FOV: 45 degrees.
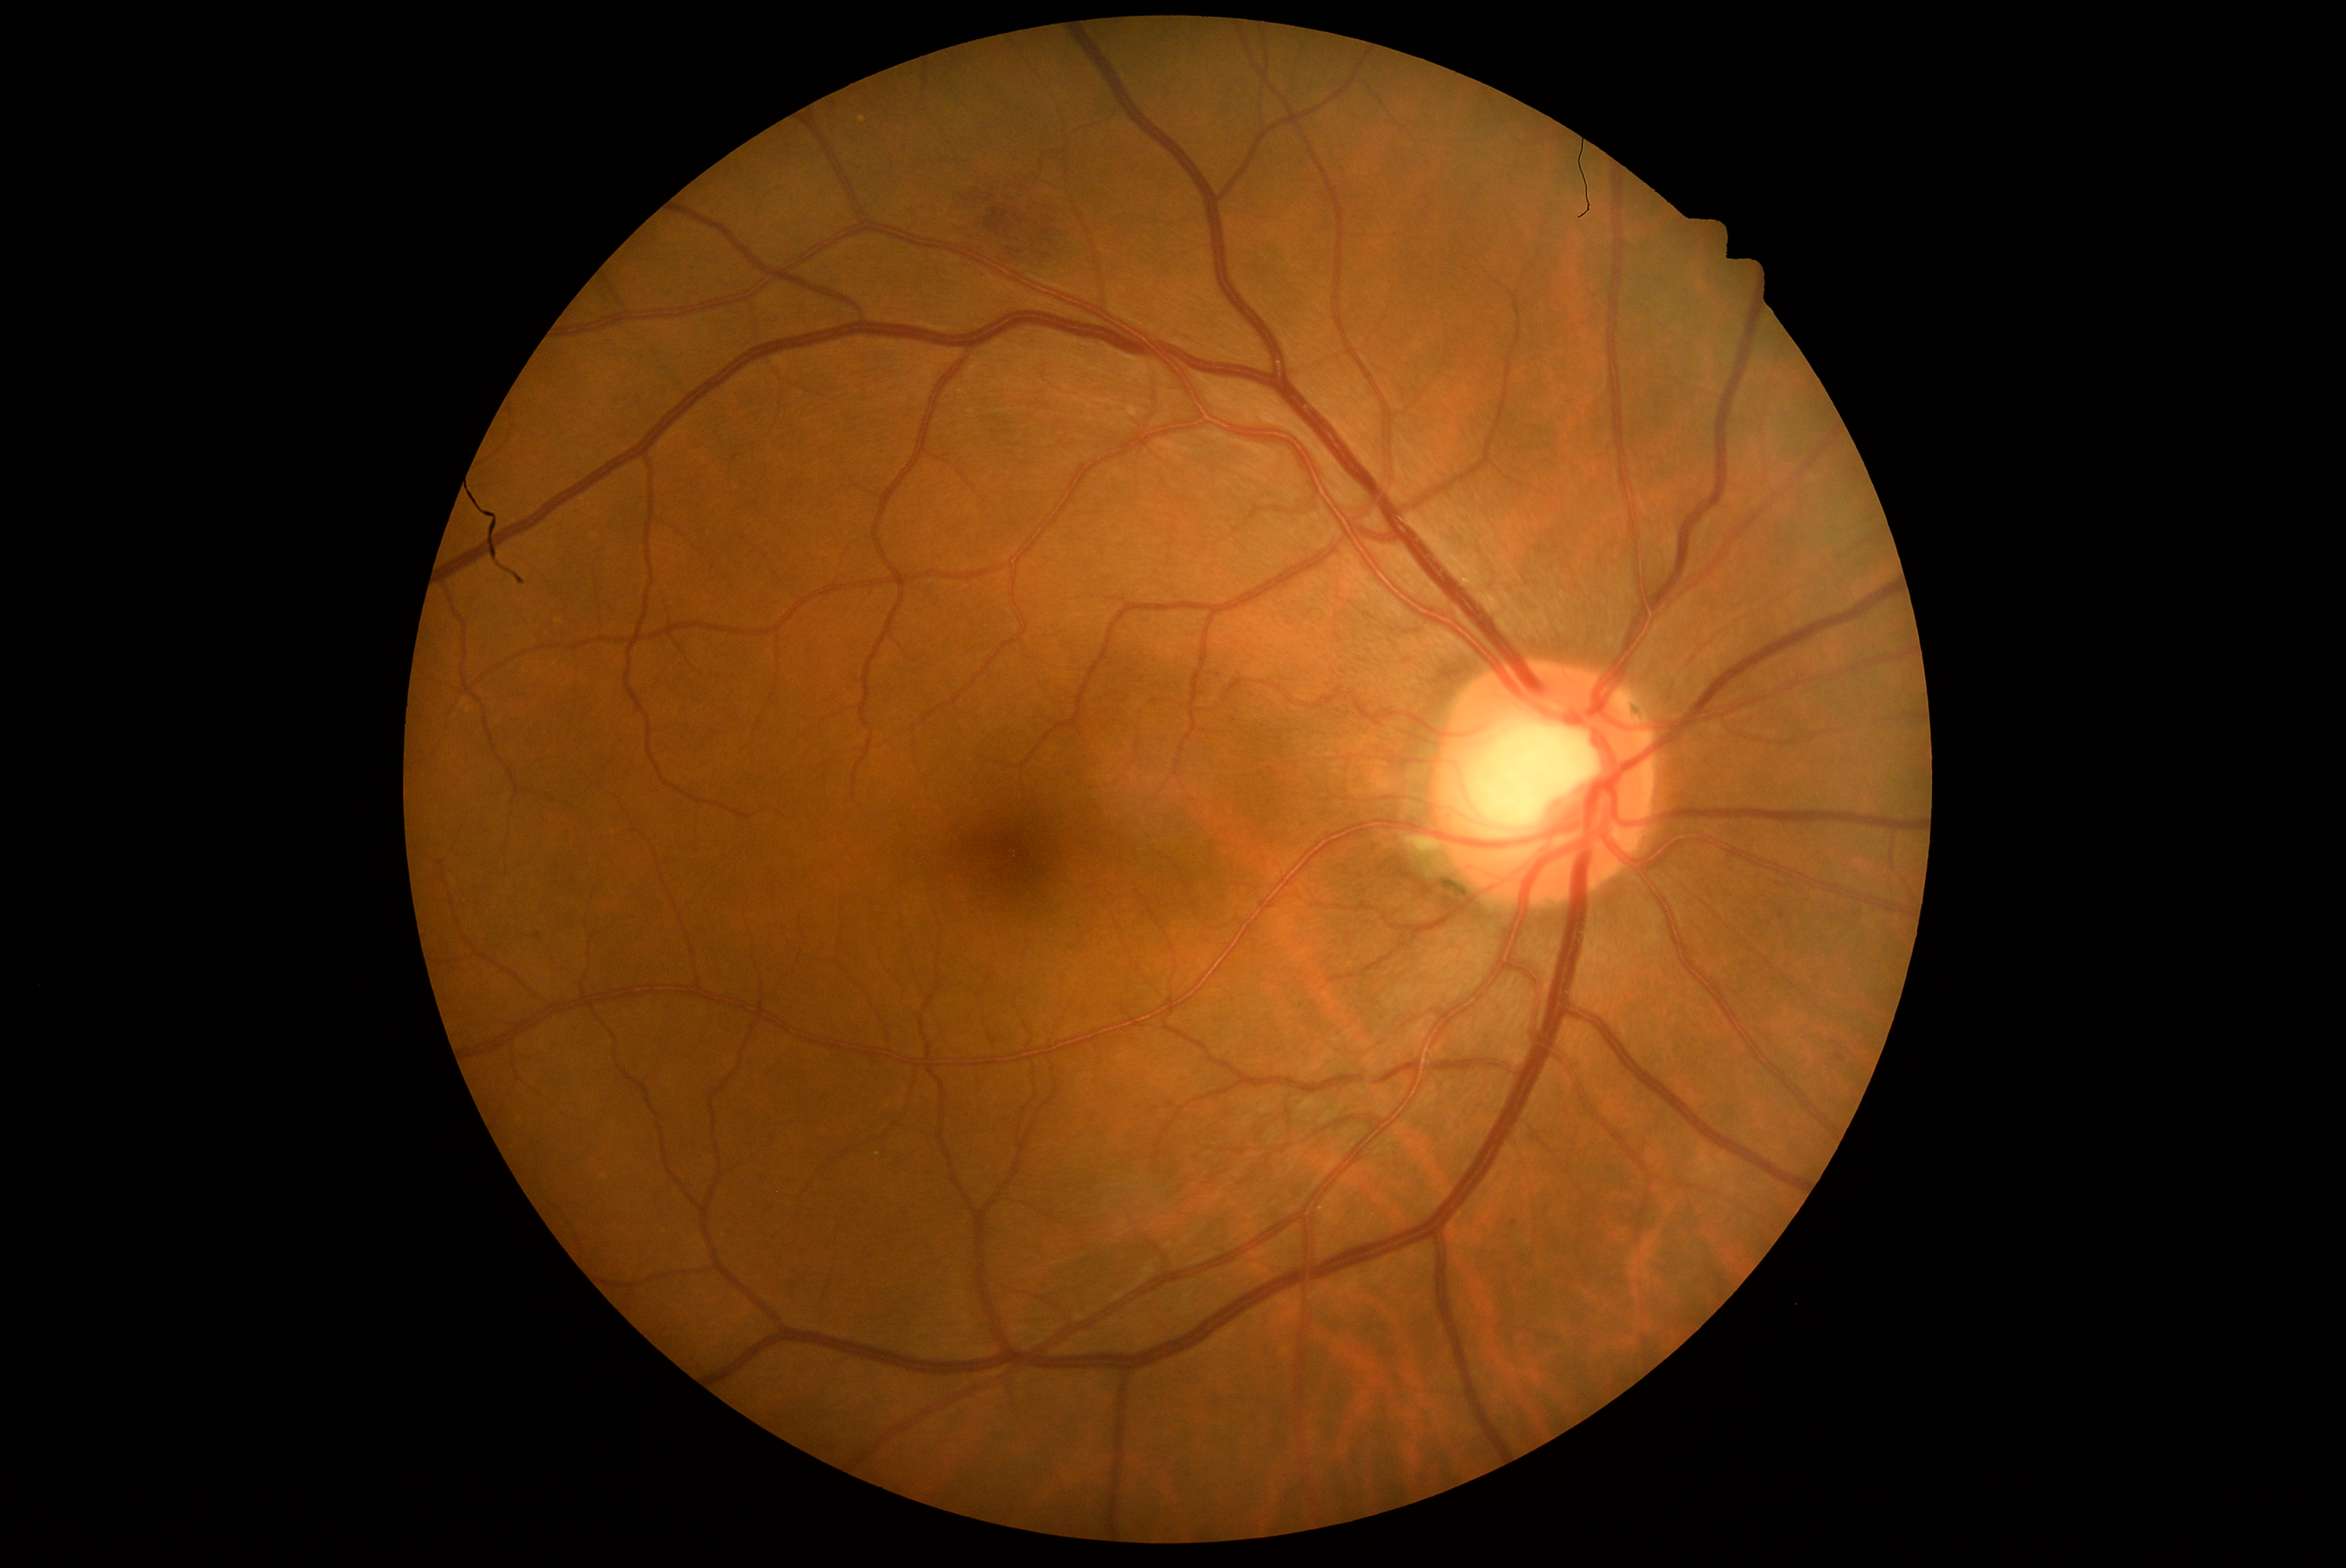
diabetic retinopathy grade@2.